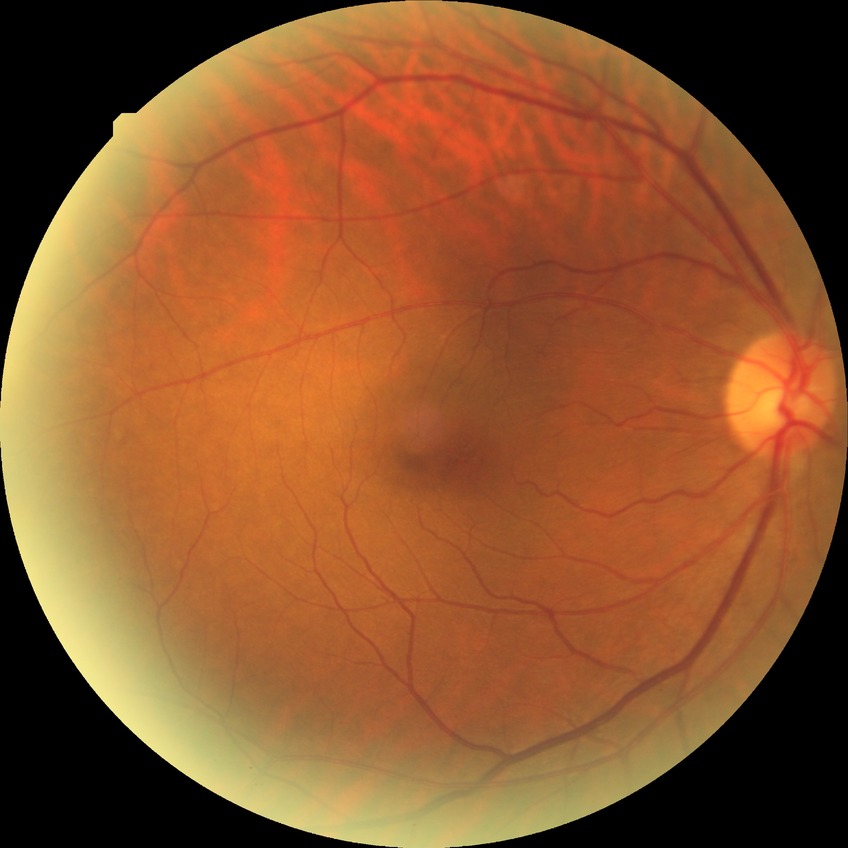

Diabetic retinopathy (DR): NDR (no diabetic retinopathy).